Fundus photo, FOV: 45 degrees: 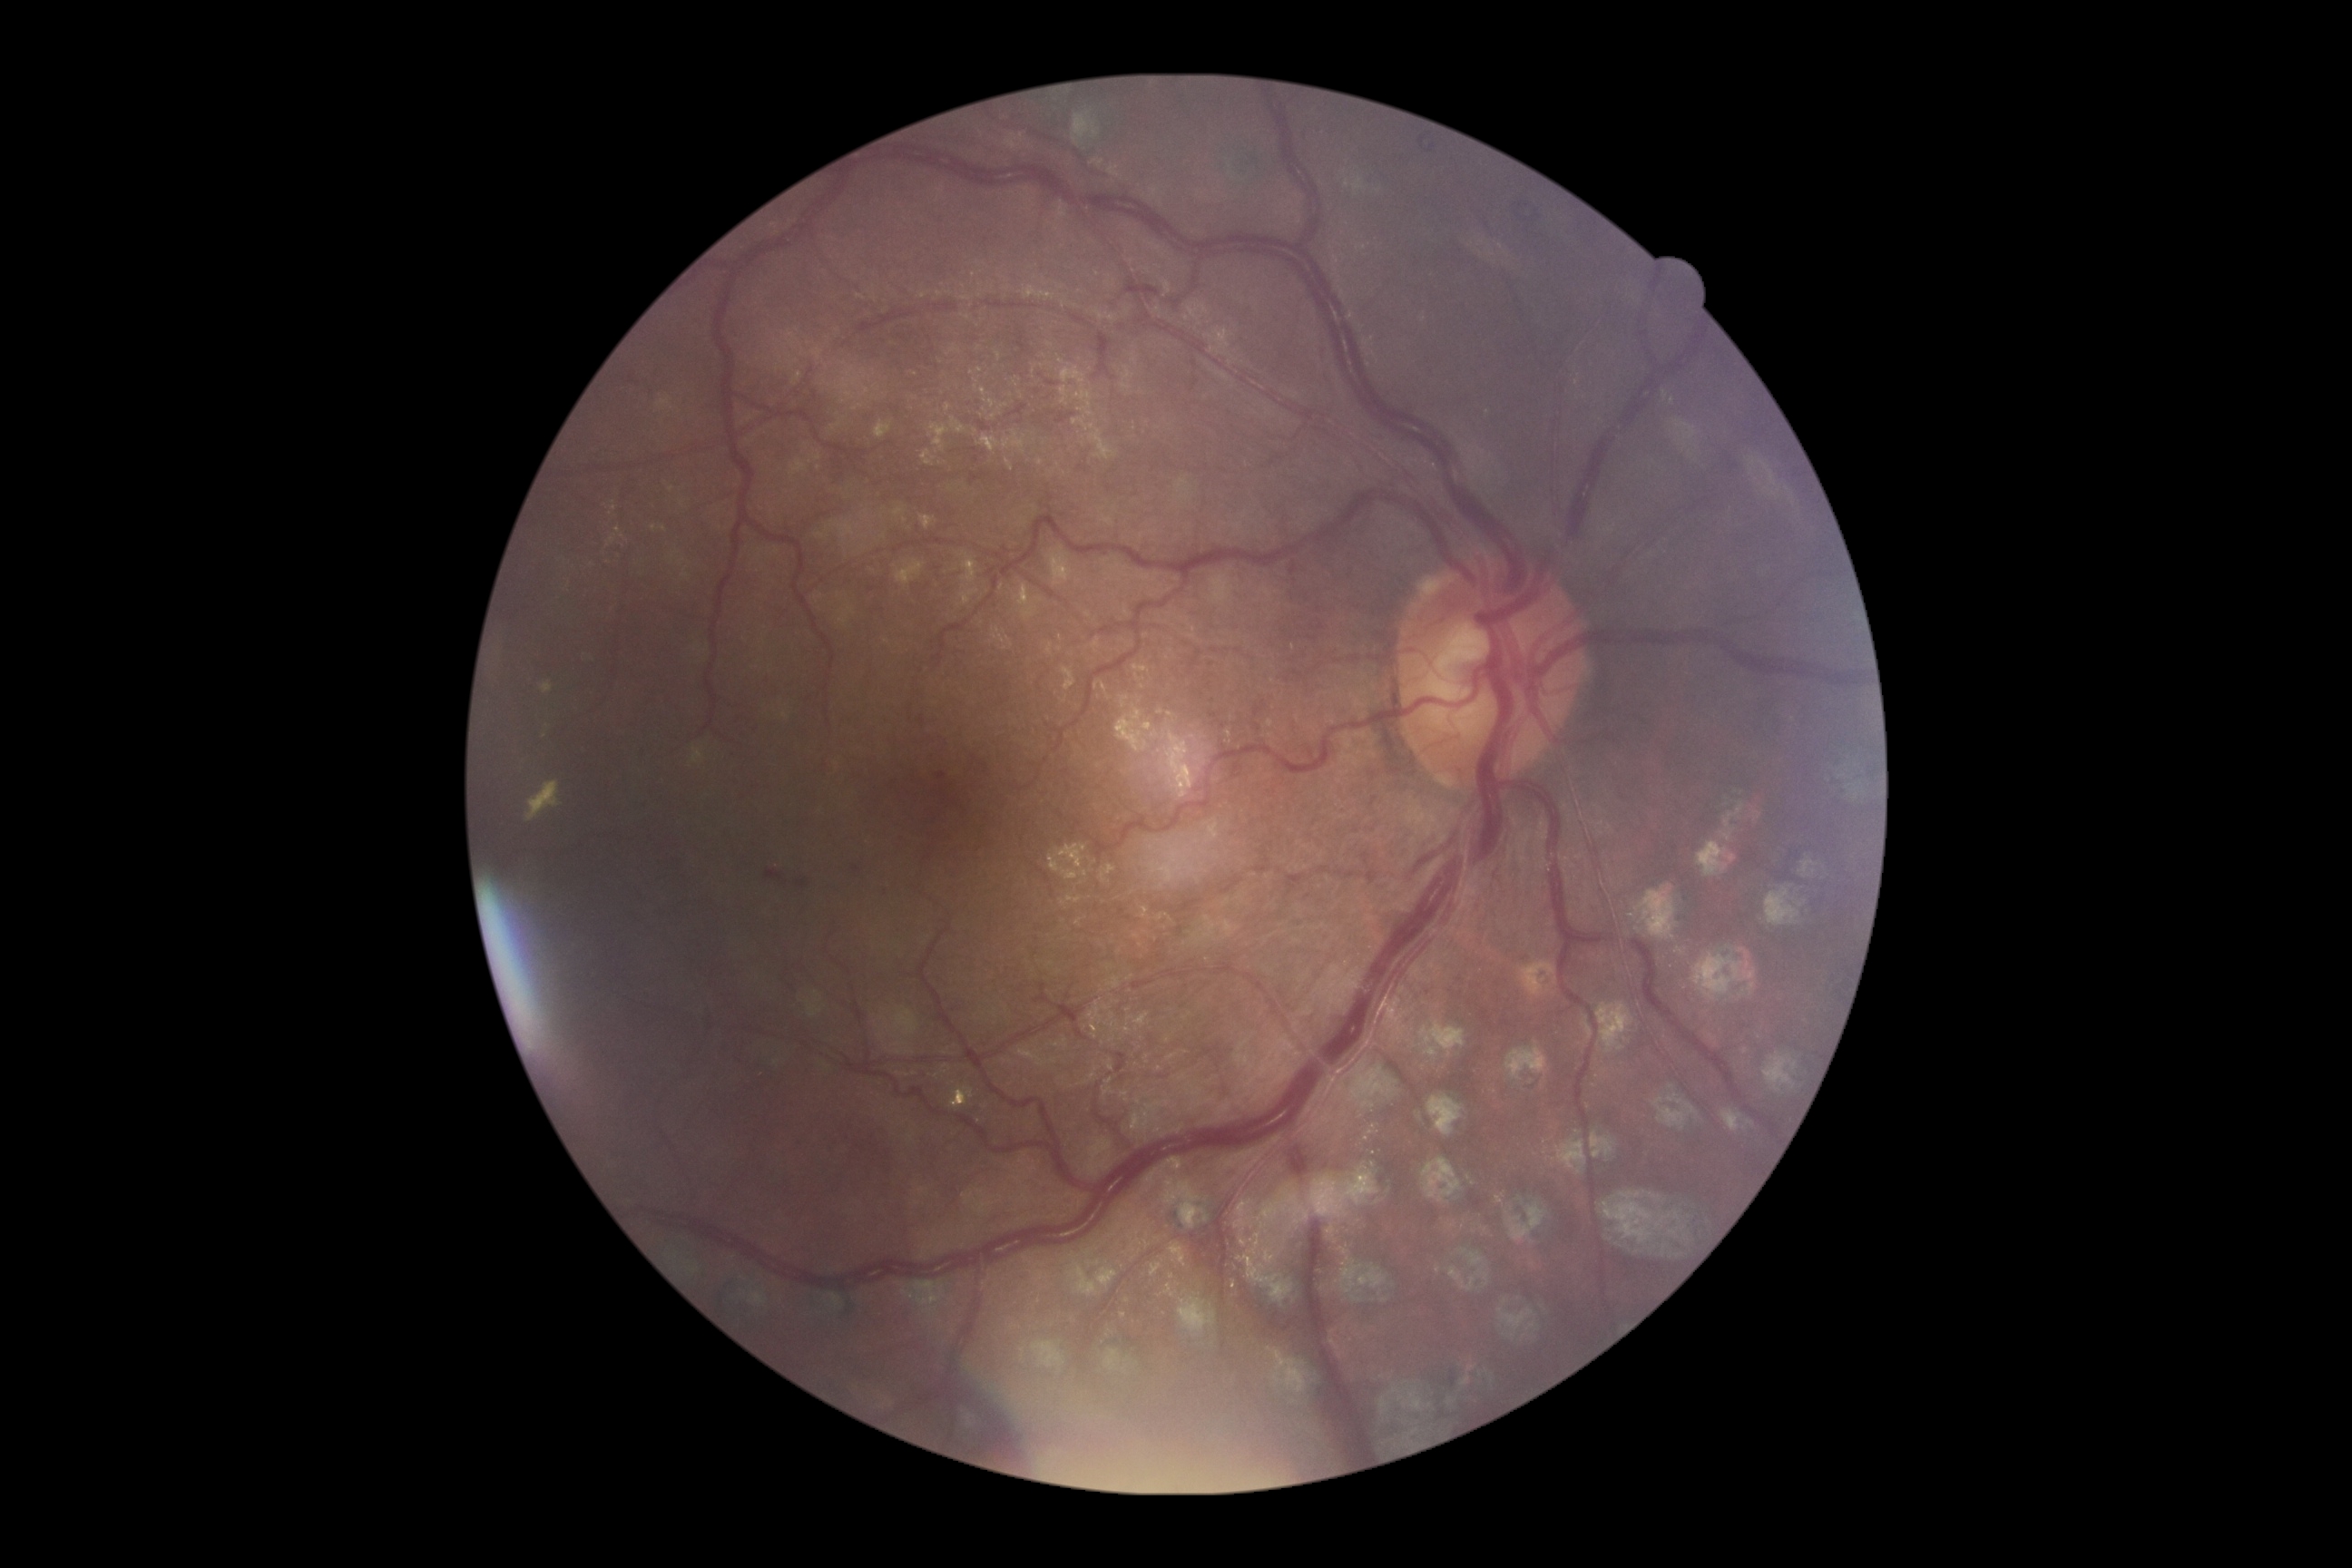

* retinopathy — moderate NPDR (grade 2)